No pharmacologic dilation; Davis DR grading:
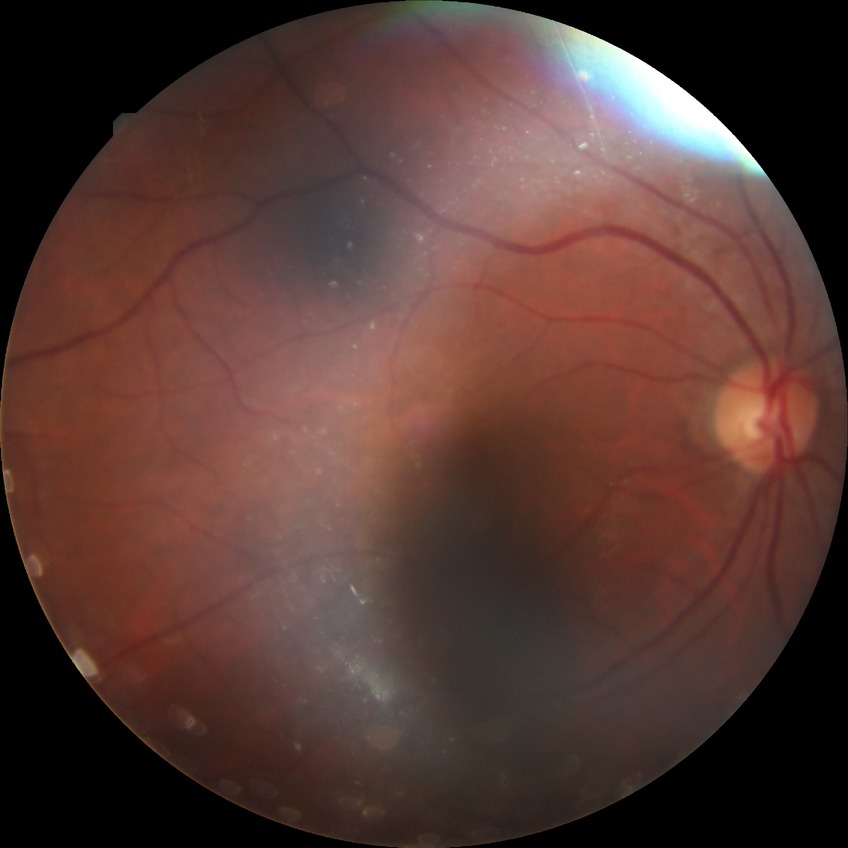   davis_grade: SDR (simple diabetic retinopathy)